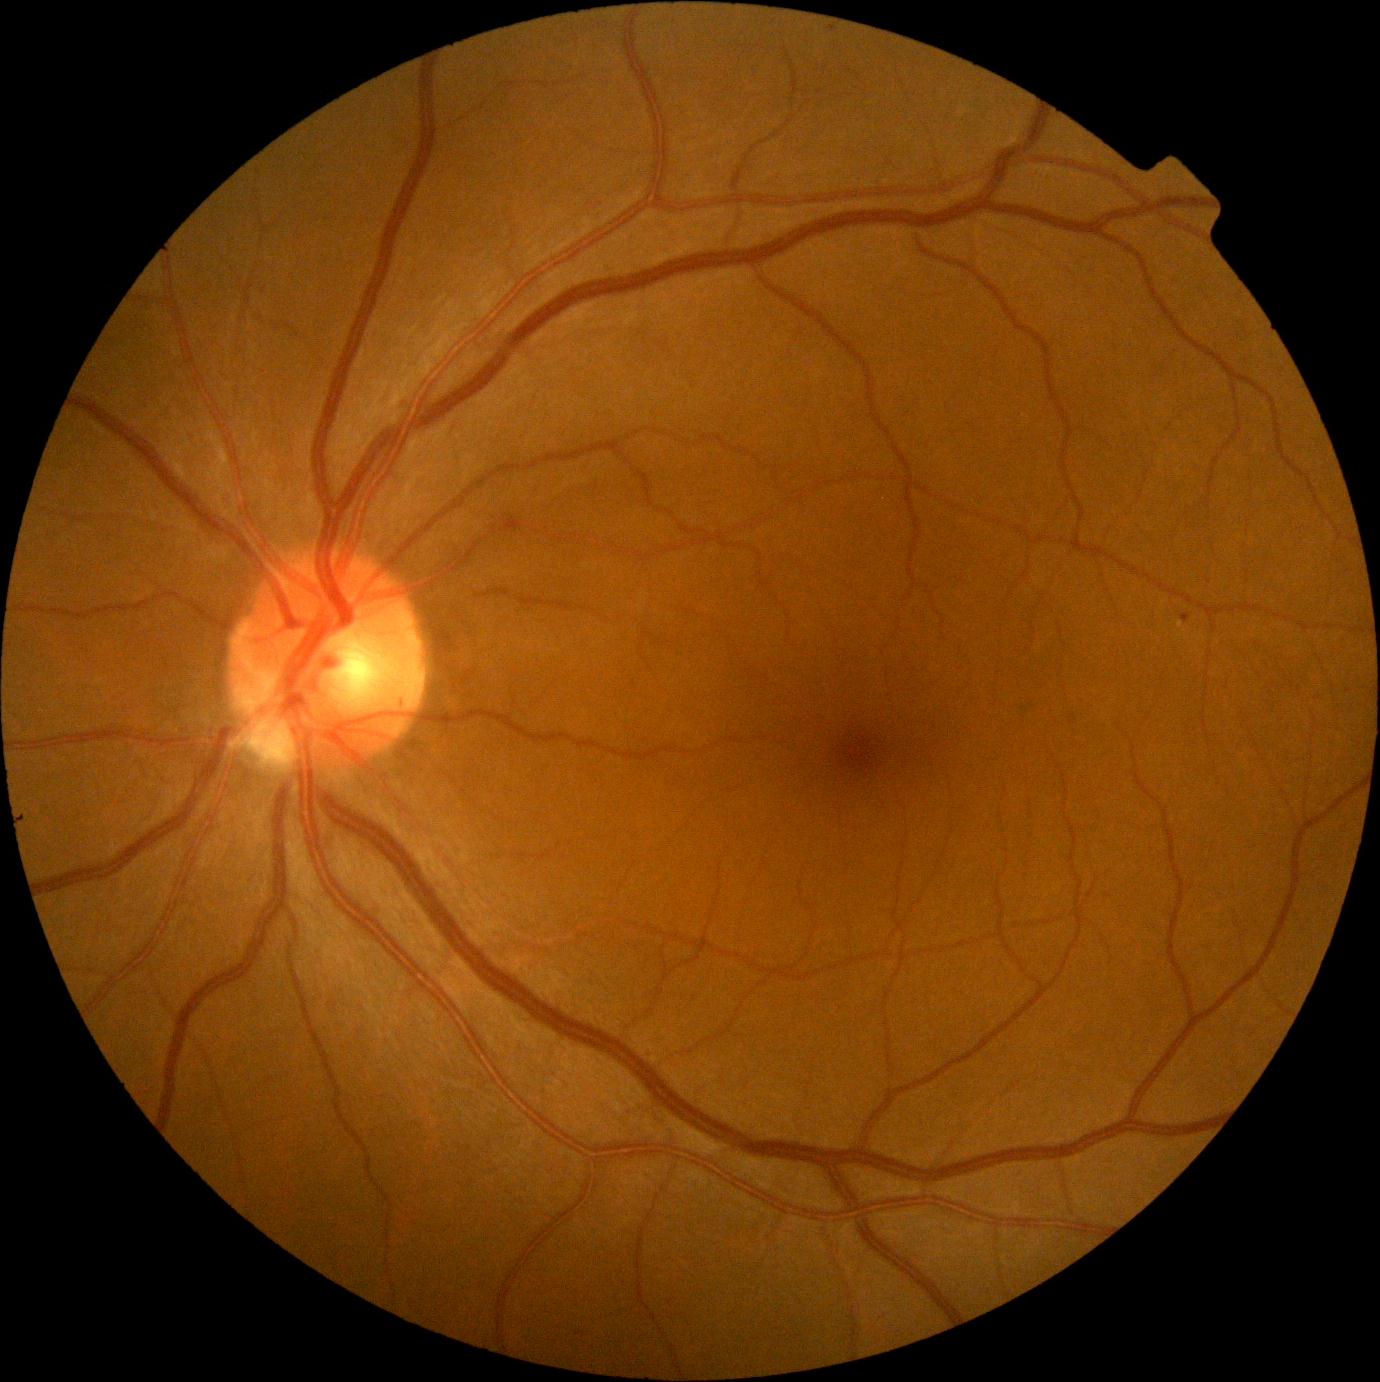
Annotations:
- diabetic retinopathy (DR): grade 1 (mild NPDR)